No pharmacologic dilation. FOV: 45 degrees:
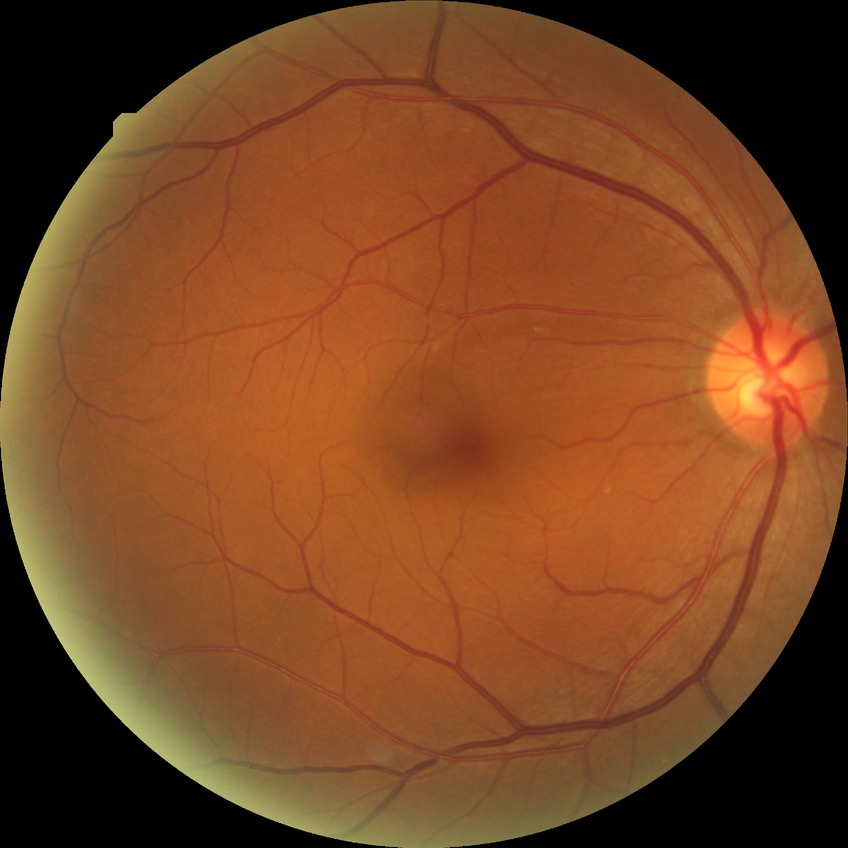
Davis grade: NDR; DR impression: no signs of DR.